240 x 240 pixels: 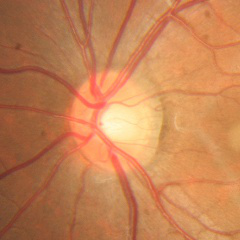

Assessment = no evidence of glaucoma.